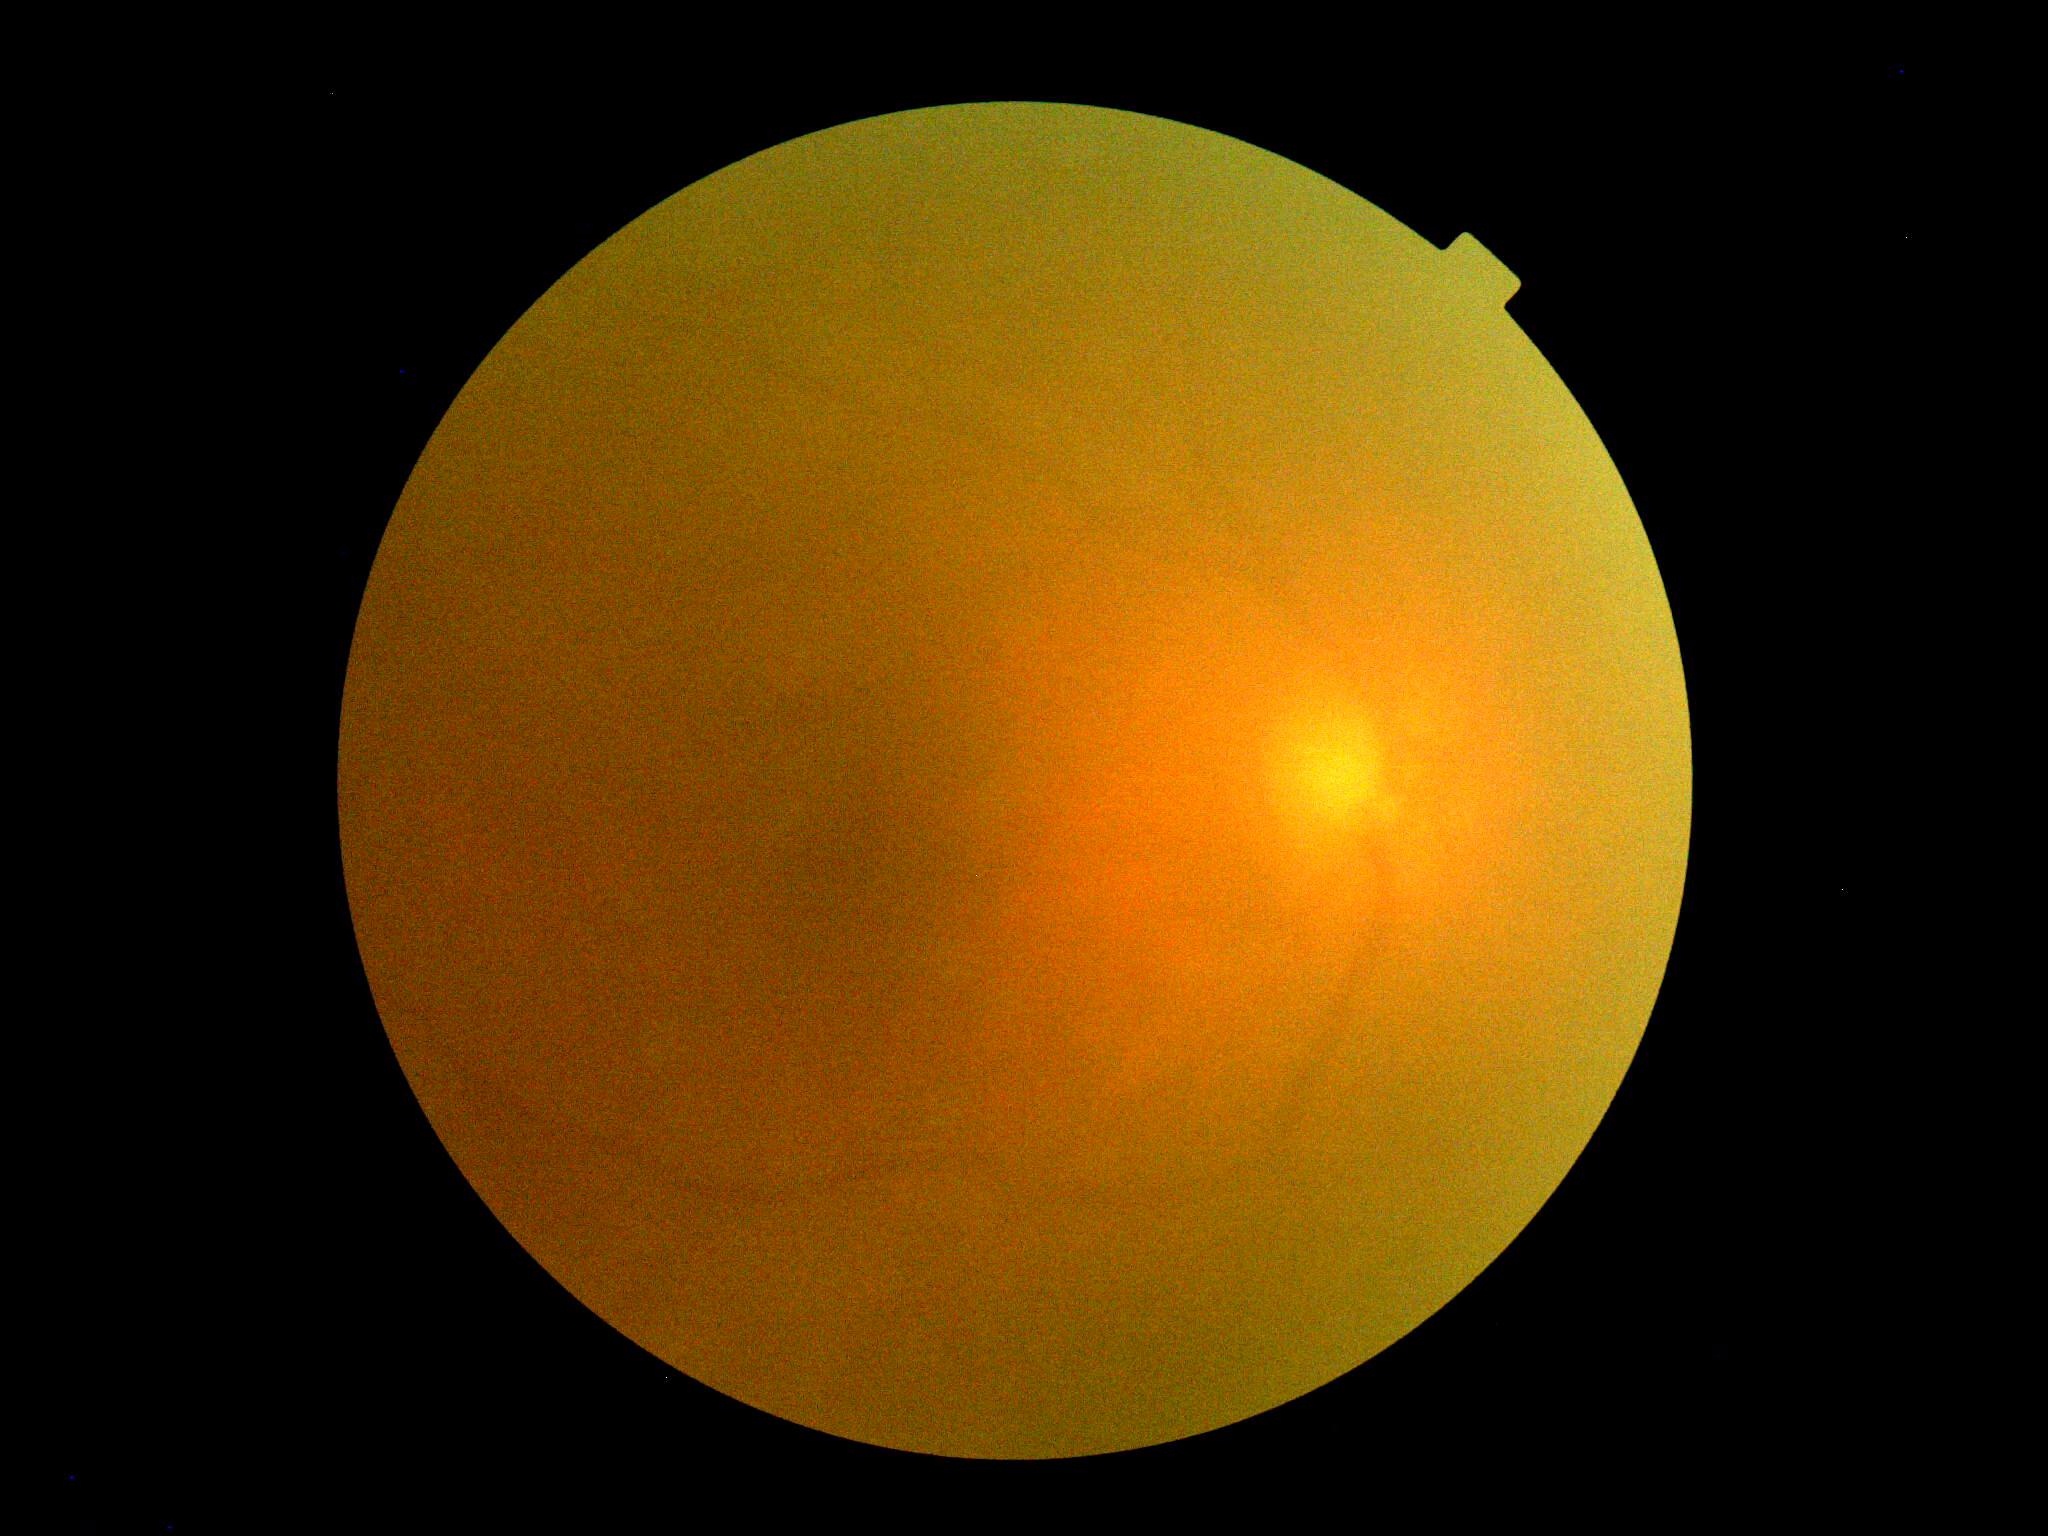 diabetic retinopathy severity@ungradable, image quality@below grading threshold.